Infant wide-field fundus photograph
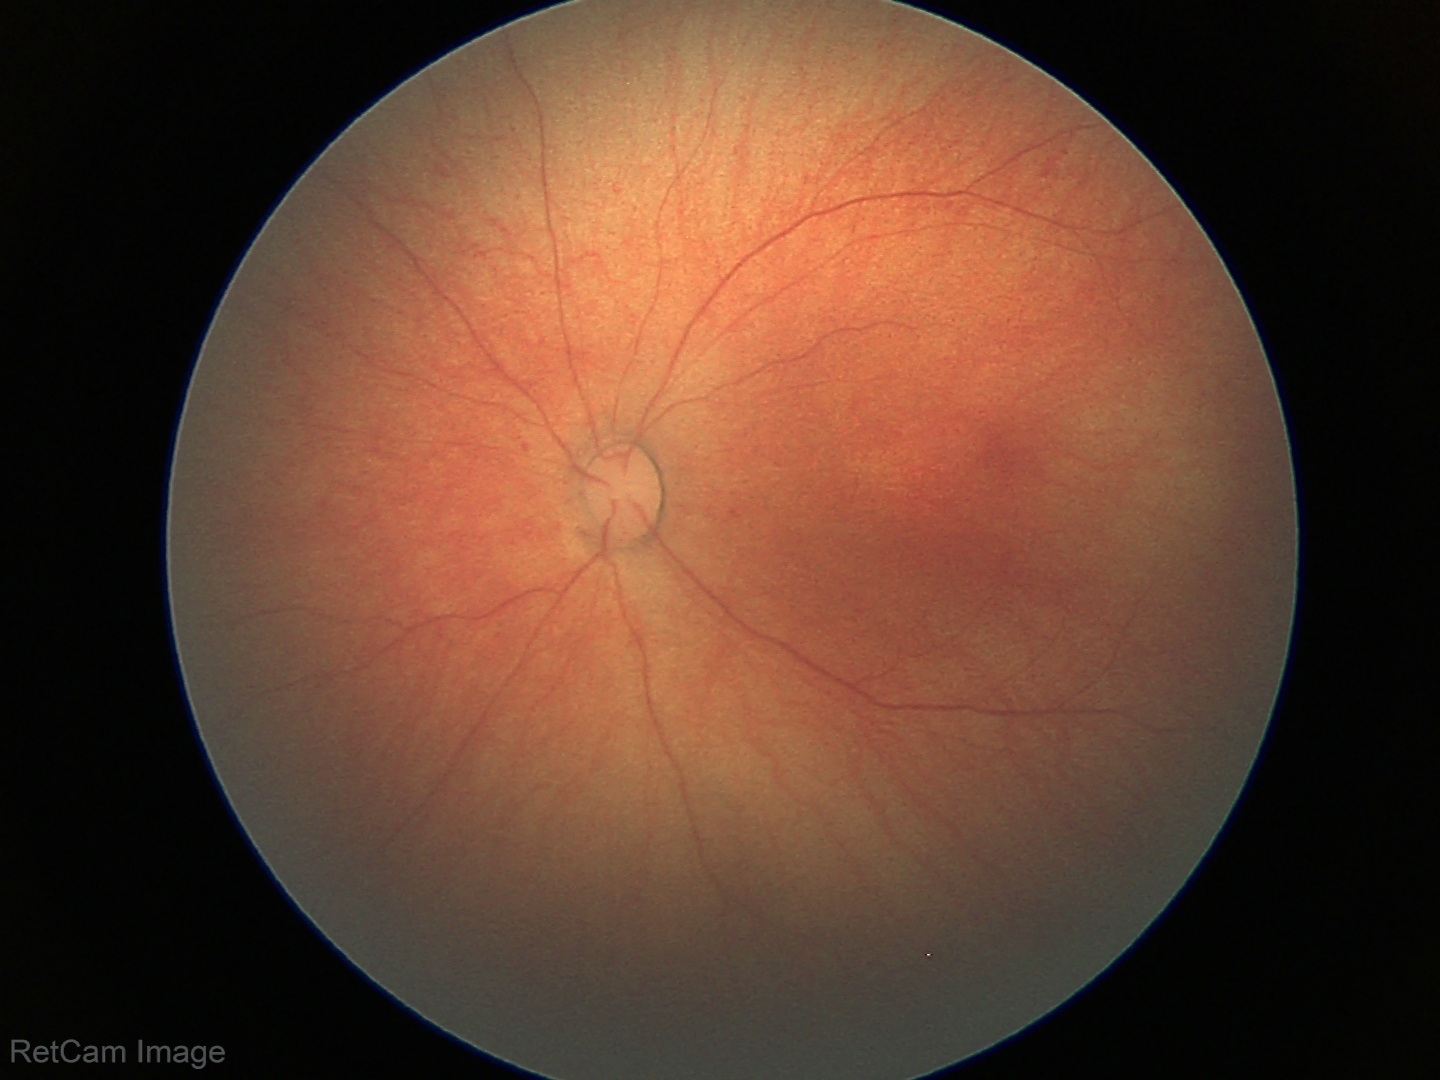 Q: What is the screening diagnosis?
A: normal fundus examination